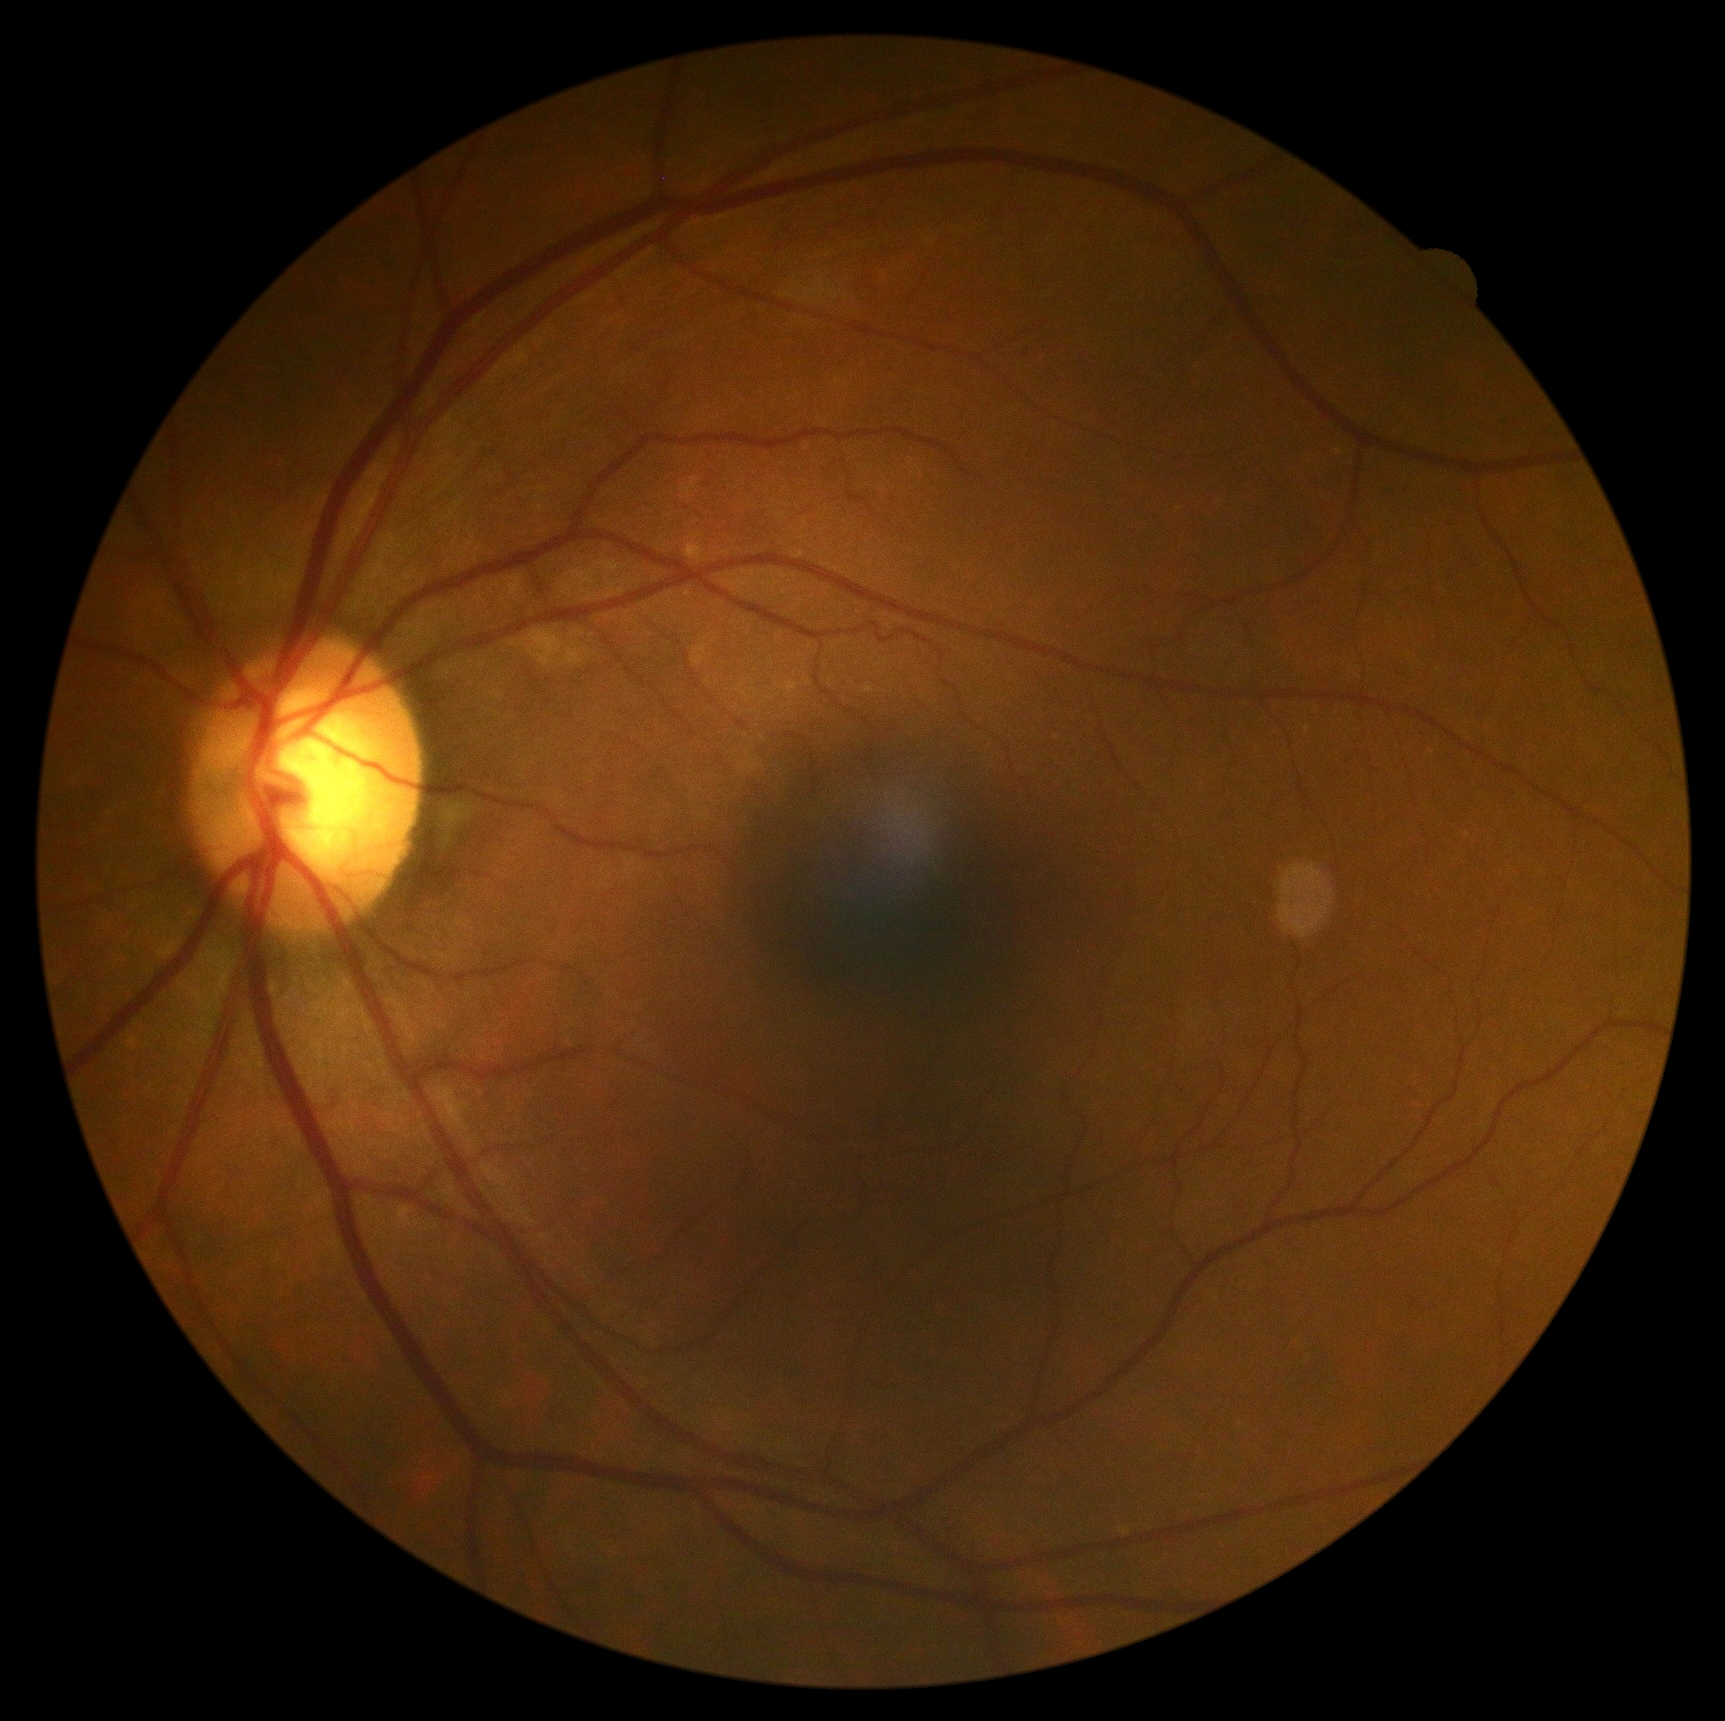
* DR severity: no apparent retinopathy (grade 0)